2212x1659px. Fundus photo. 45-degree field of view:
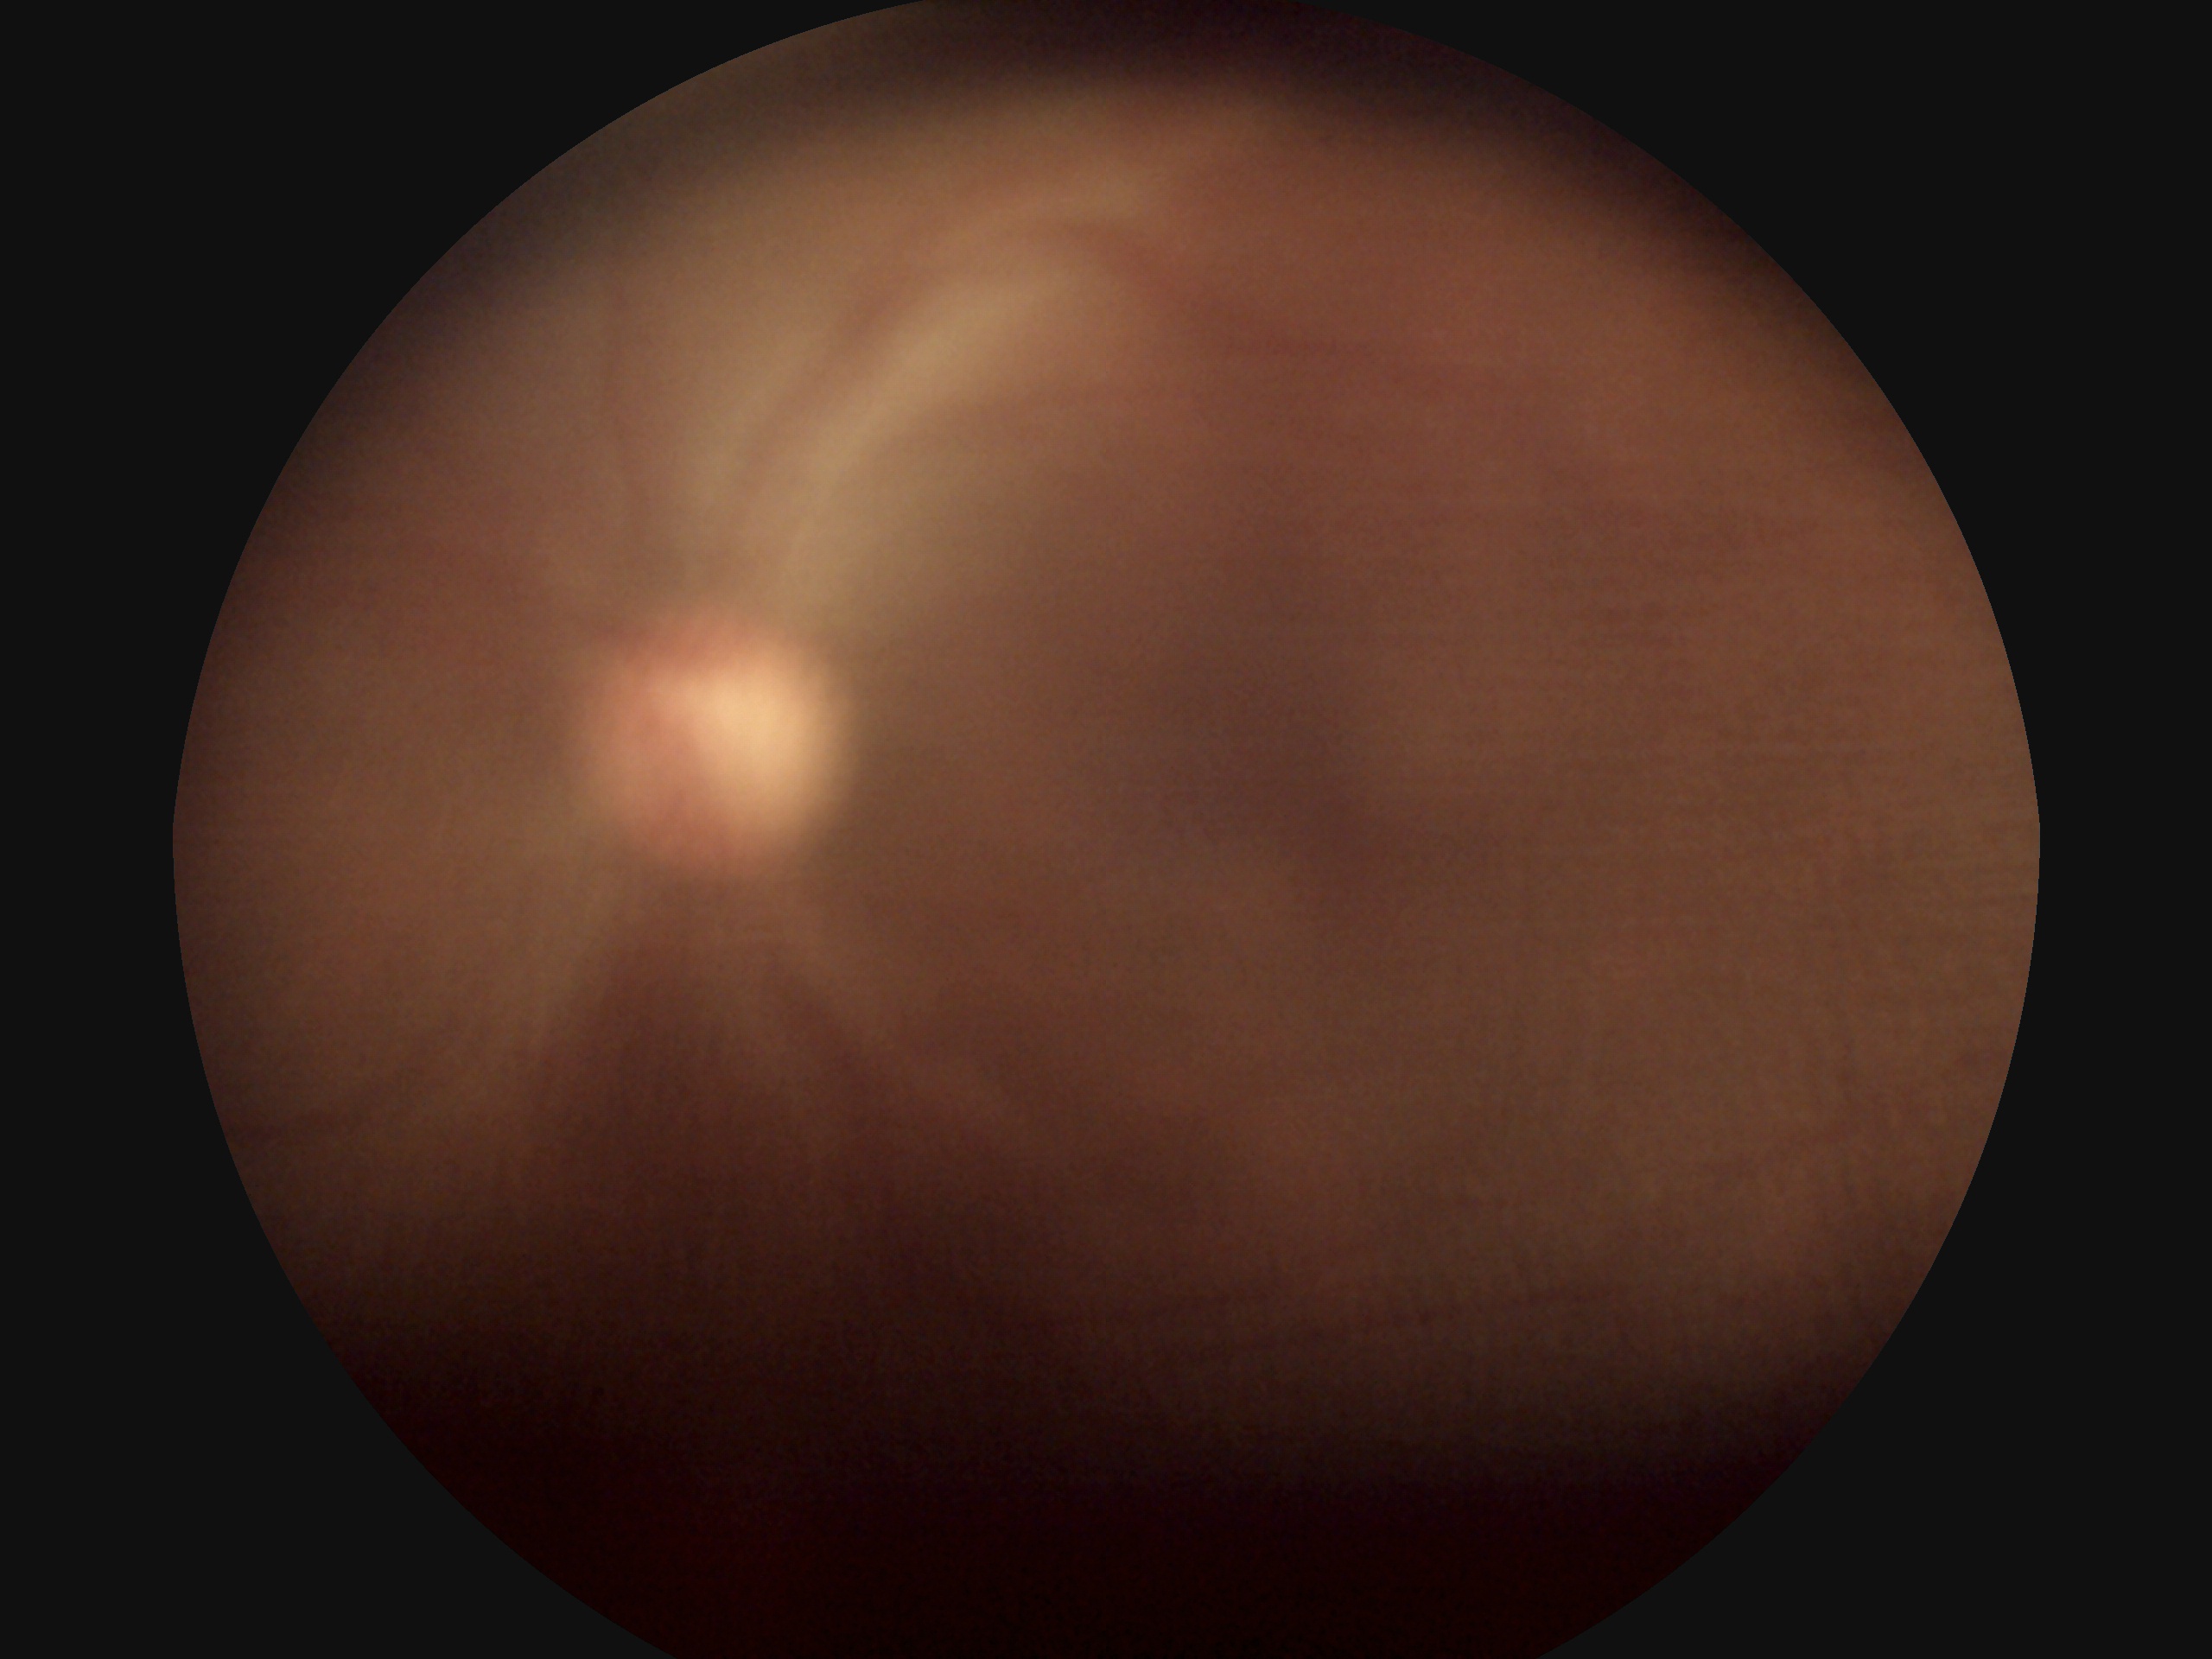 dr_grade: ungradable due to poor image quality
quality: insufficient